45° FOV, image size 848x848, acquired with a NIDEK AFC-230, posterior pole color fundus photograph, without pupil dilation: 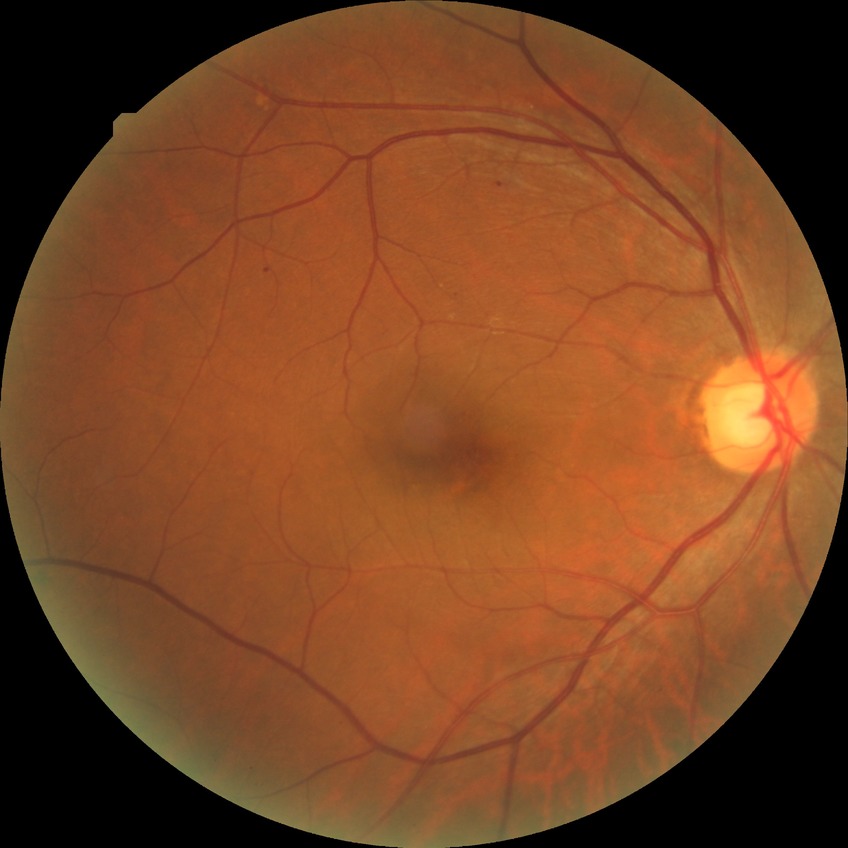
Assessment:
– DR — SDR